Infant wide-field retinal image — 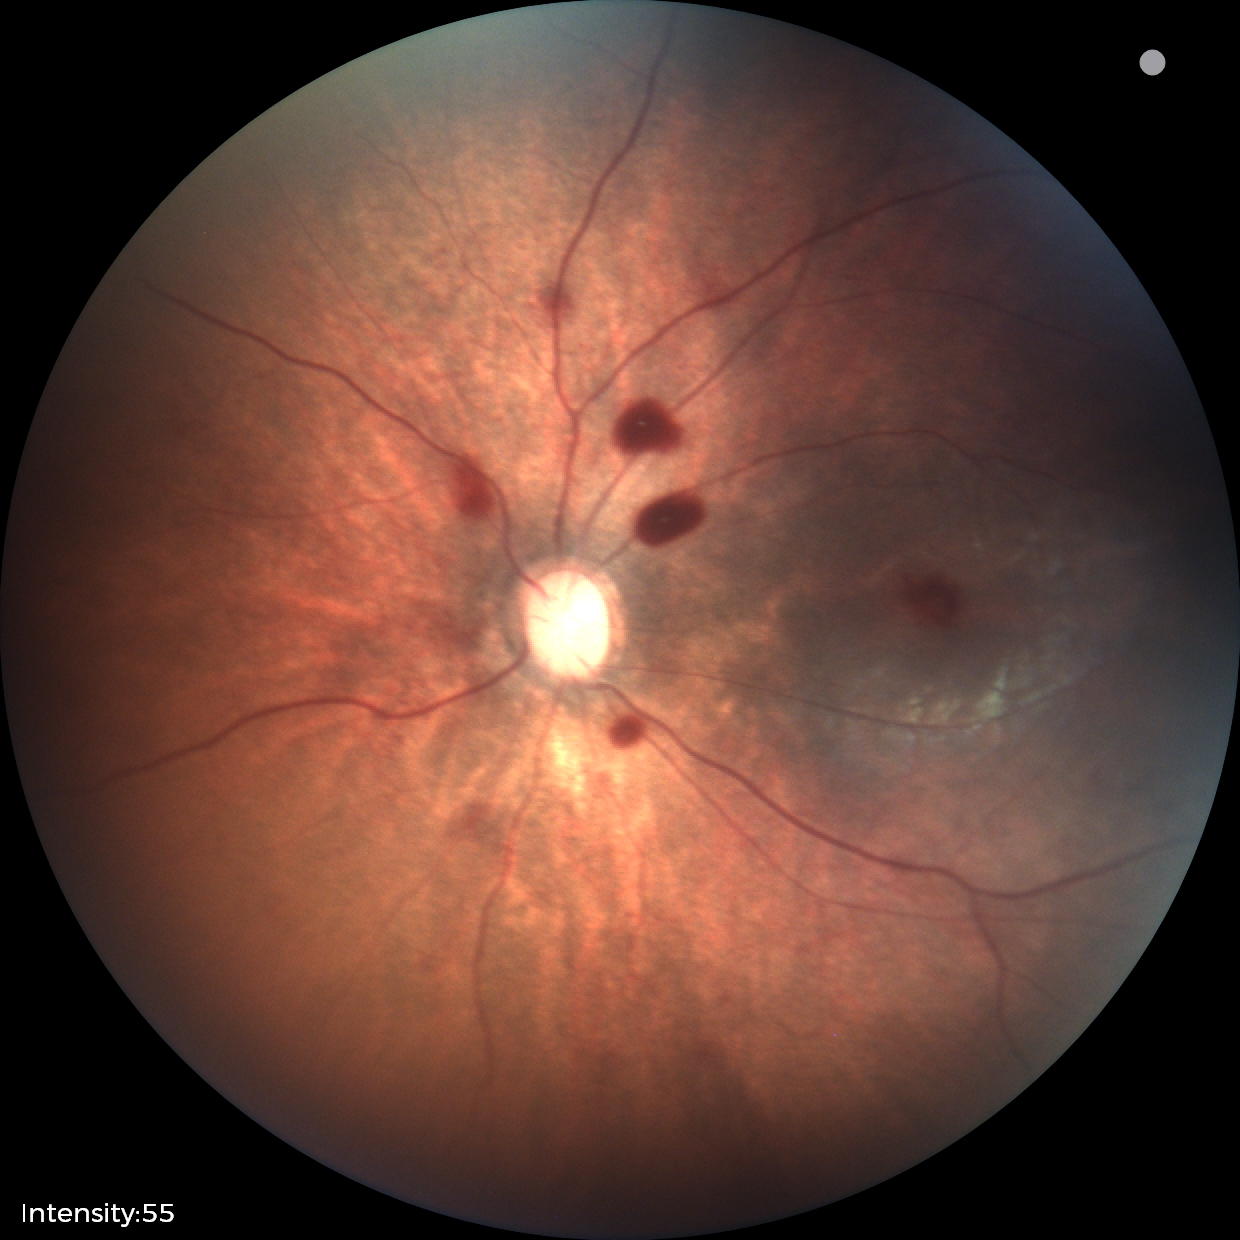
Screening series with retinal hemorrhages.